FOV: 30 degrees. 53-year-old patient. Optic disc at the center of the field. Perimetry mean defect: -0.58 dB. Axial length (AL): 21.73 mm.
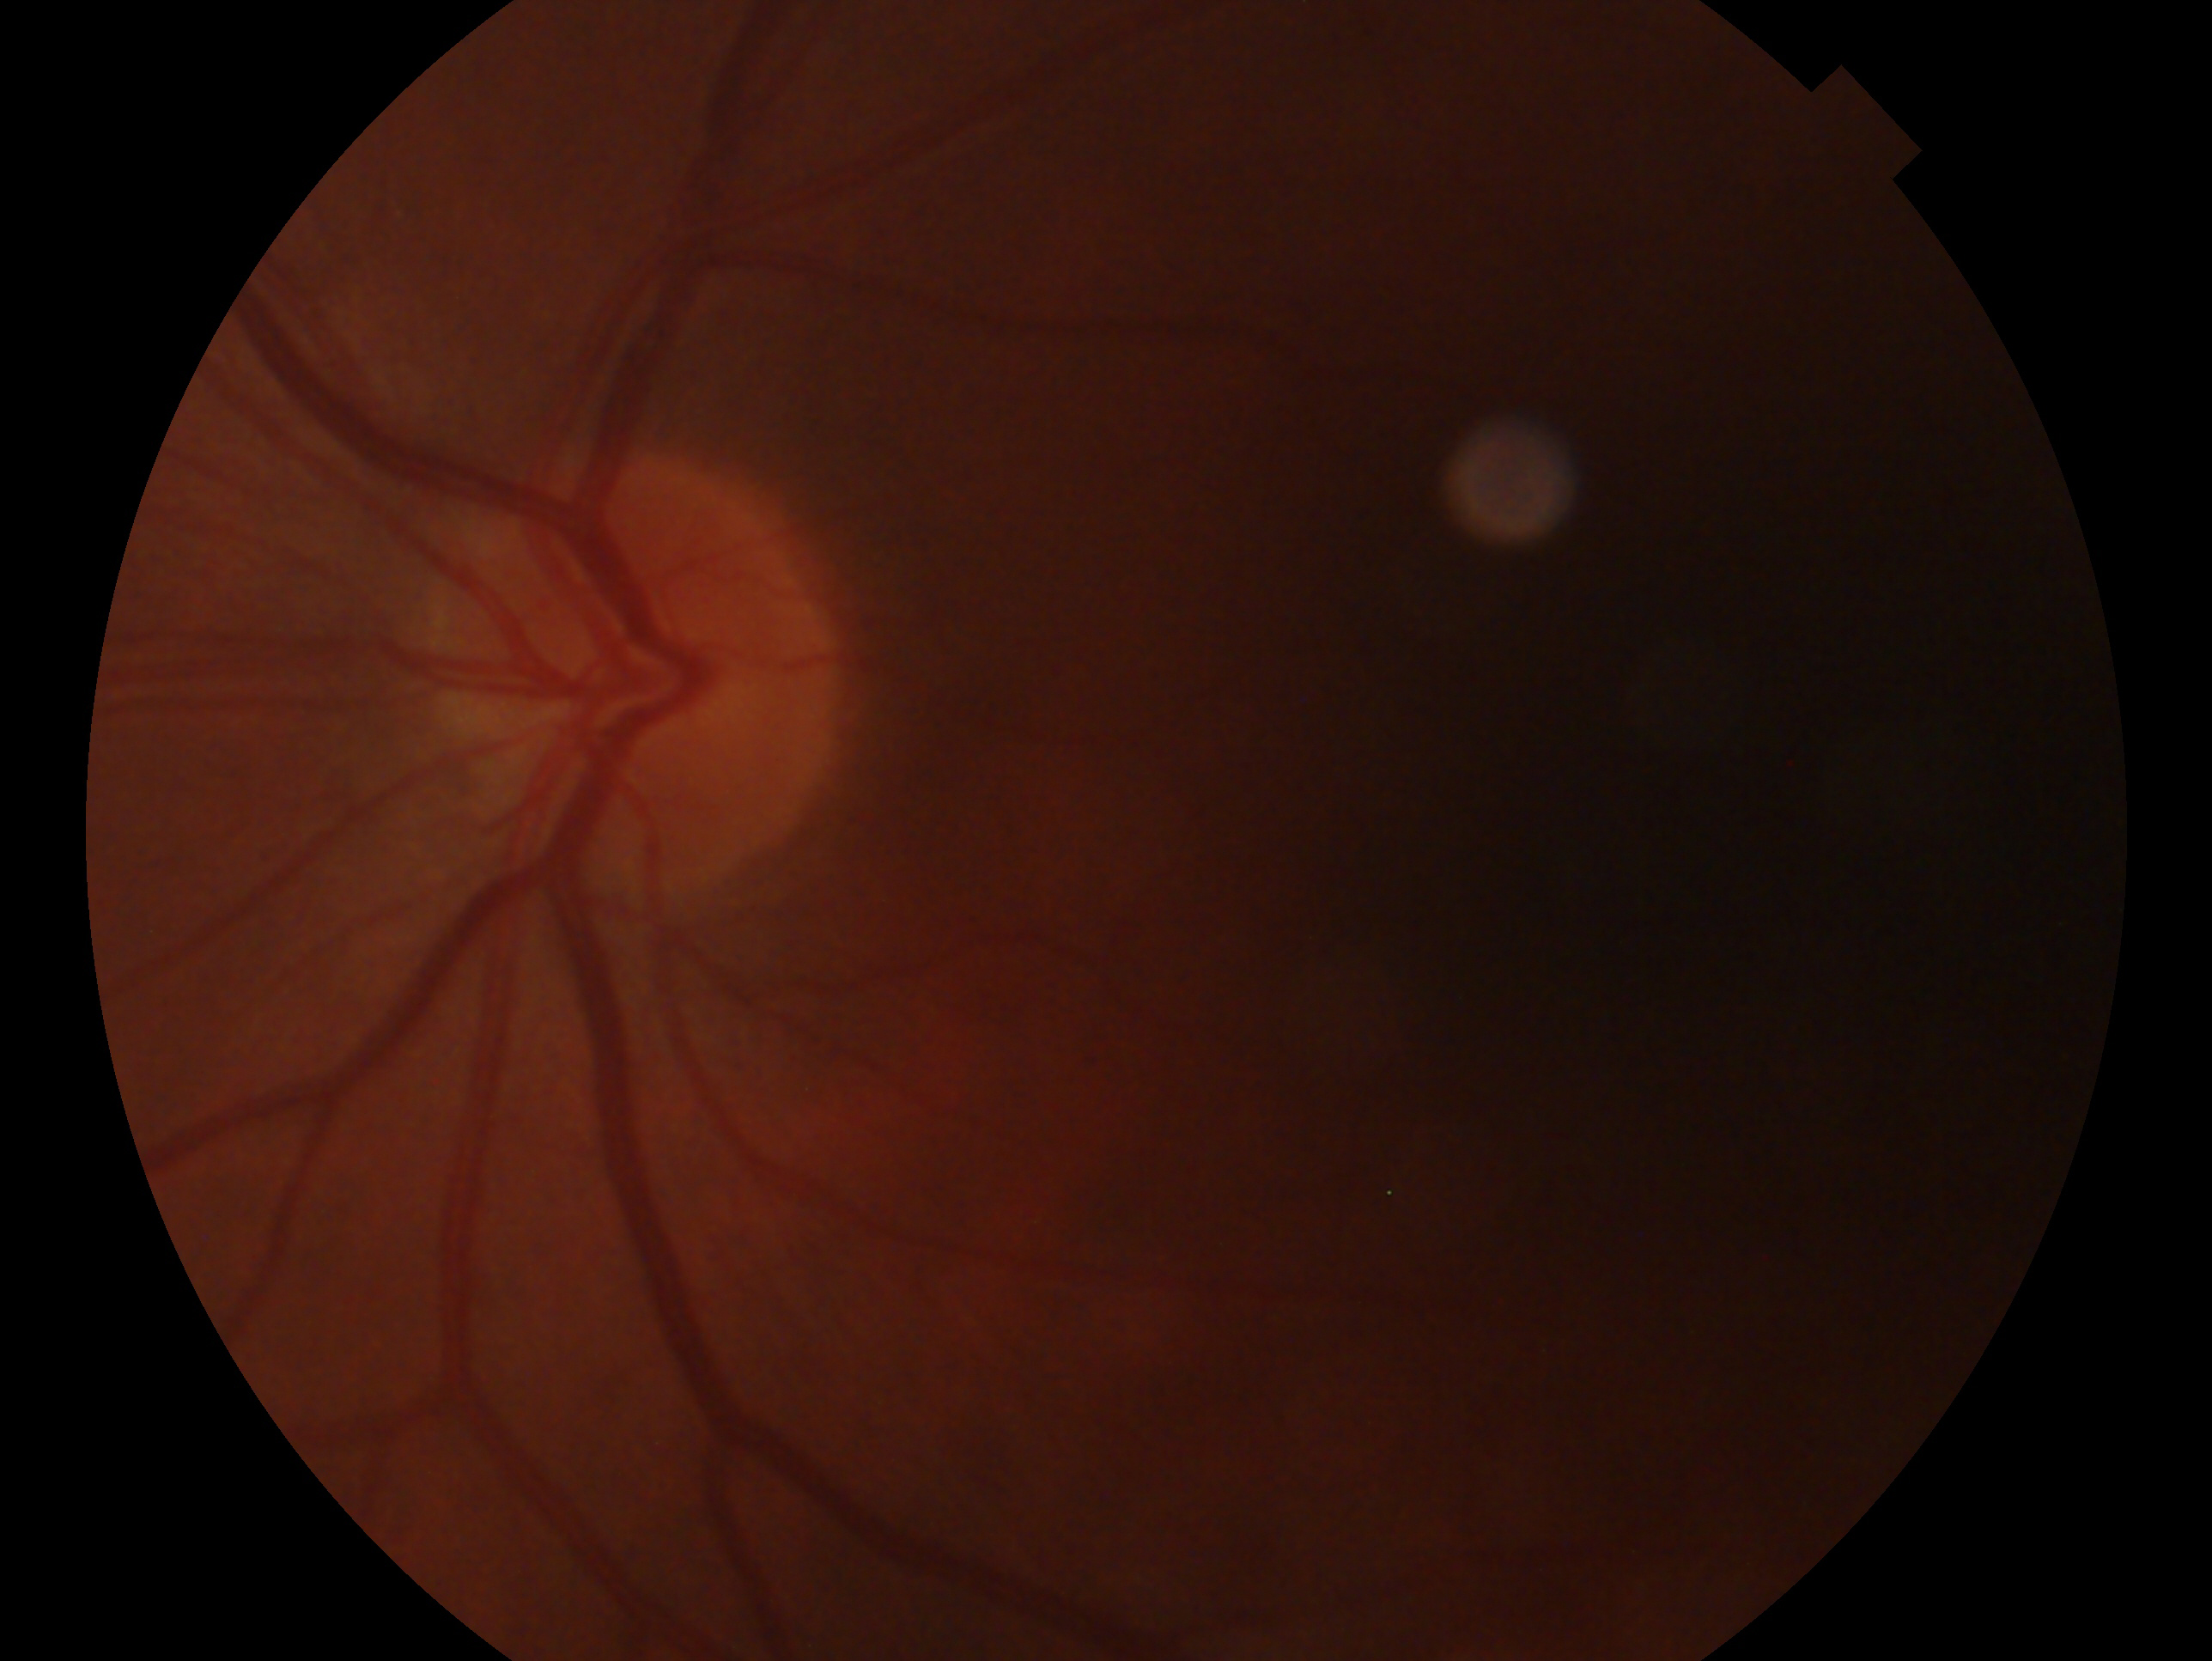 Imaged eye: OS.
Assessment: suspected glaucoma.